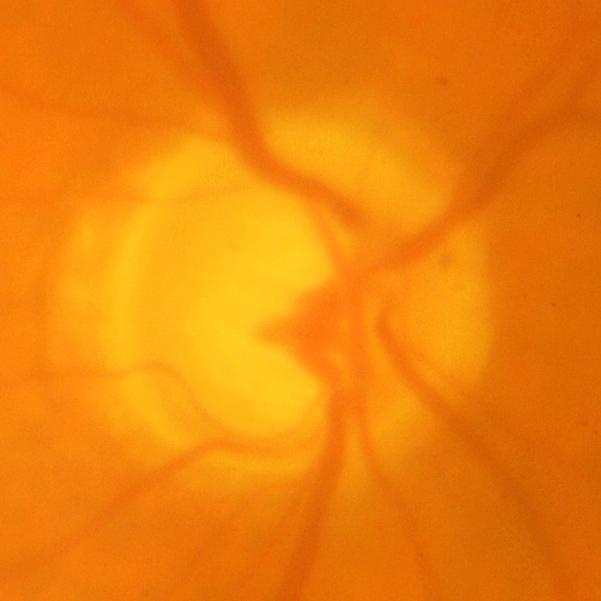
Glaucomatous optic neuropathy is present. Assessment = glaucomatous findings.